Infant wide-field retinal image; 1240x1240:
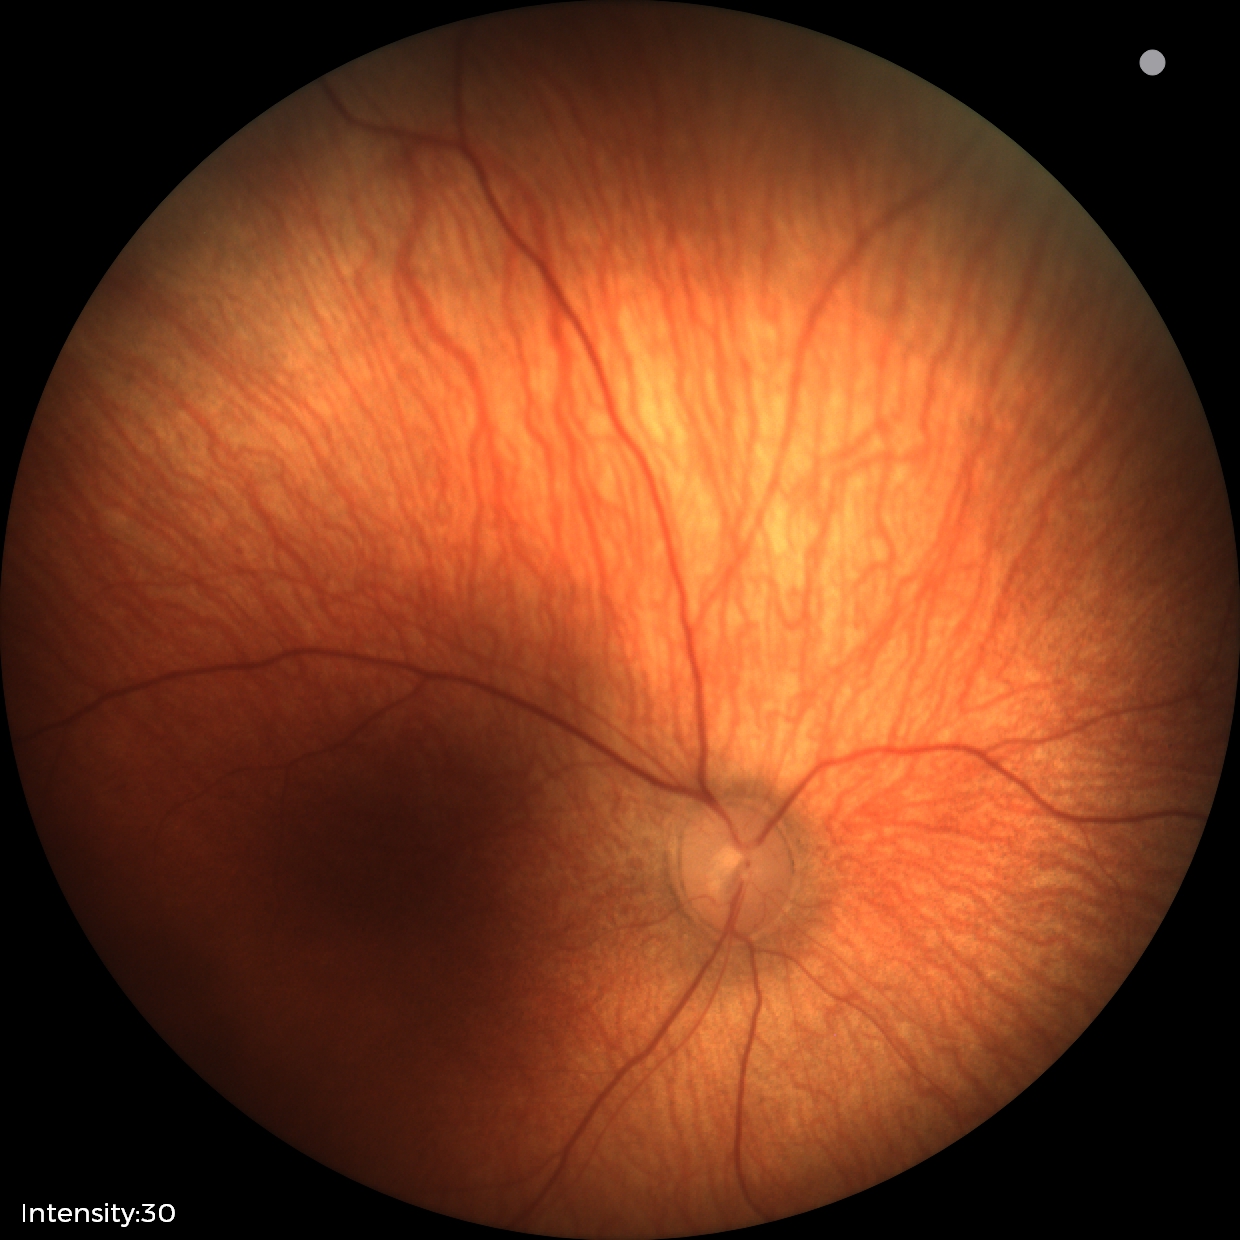
Screening examination with no abnormal retinal findings.